CFP
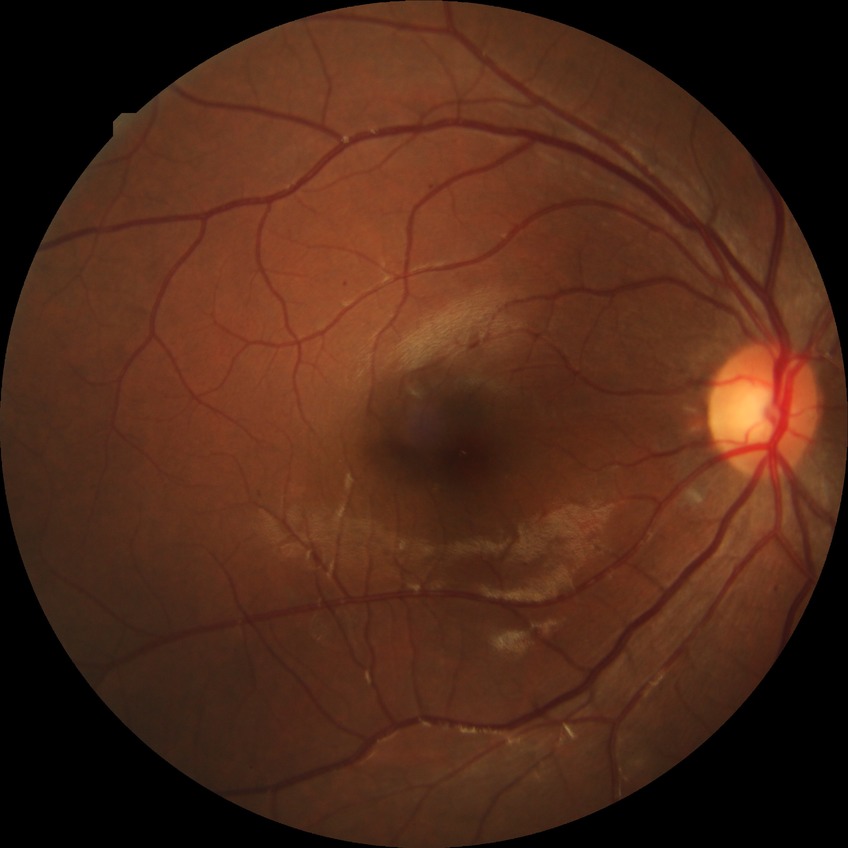
diabetic retinopathy (DR) = SDR (simple diabetic retinopathy)